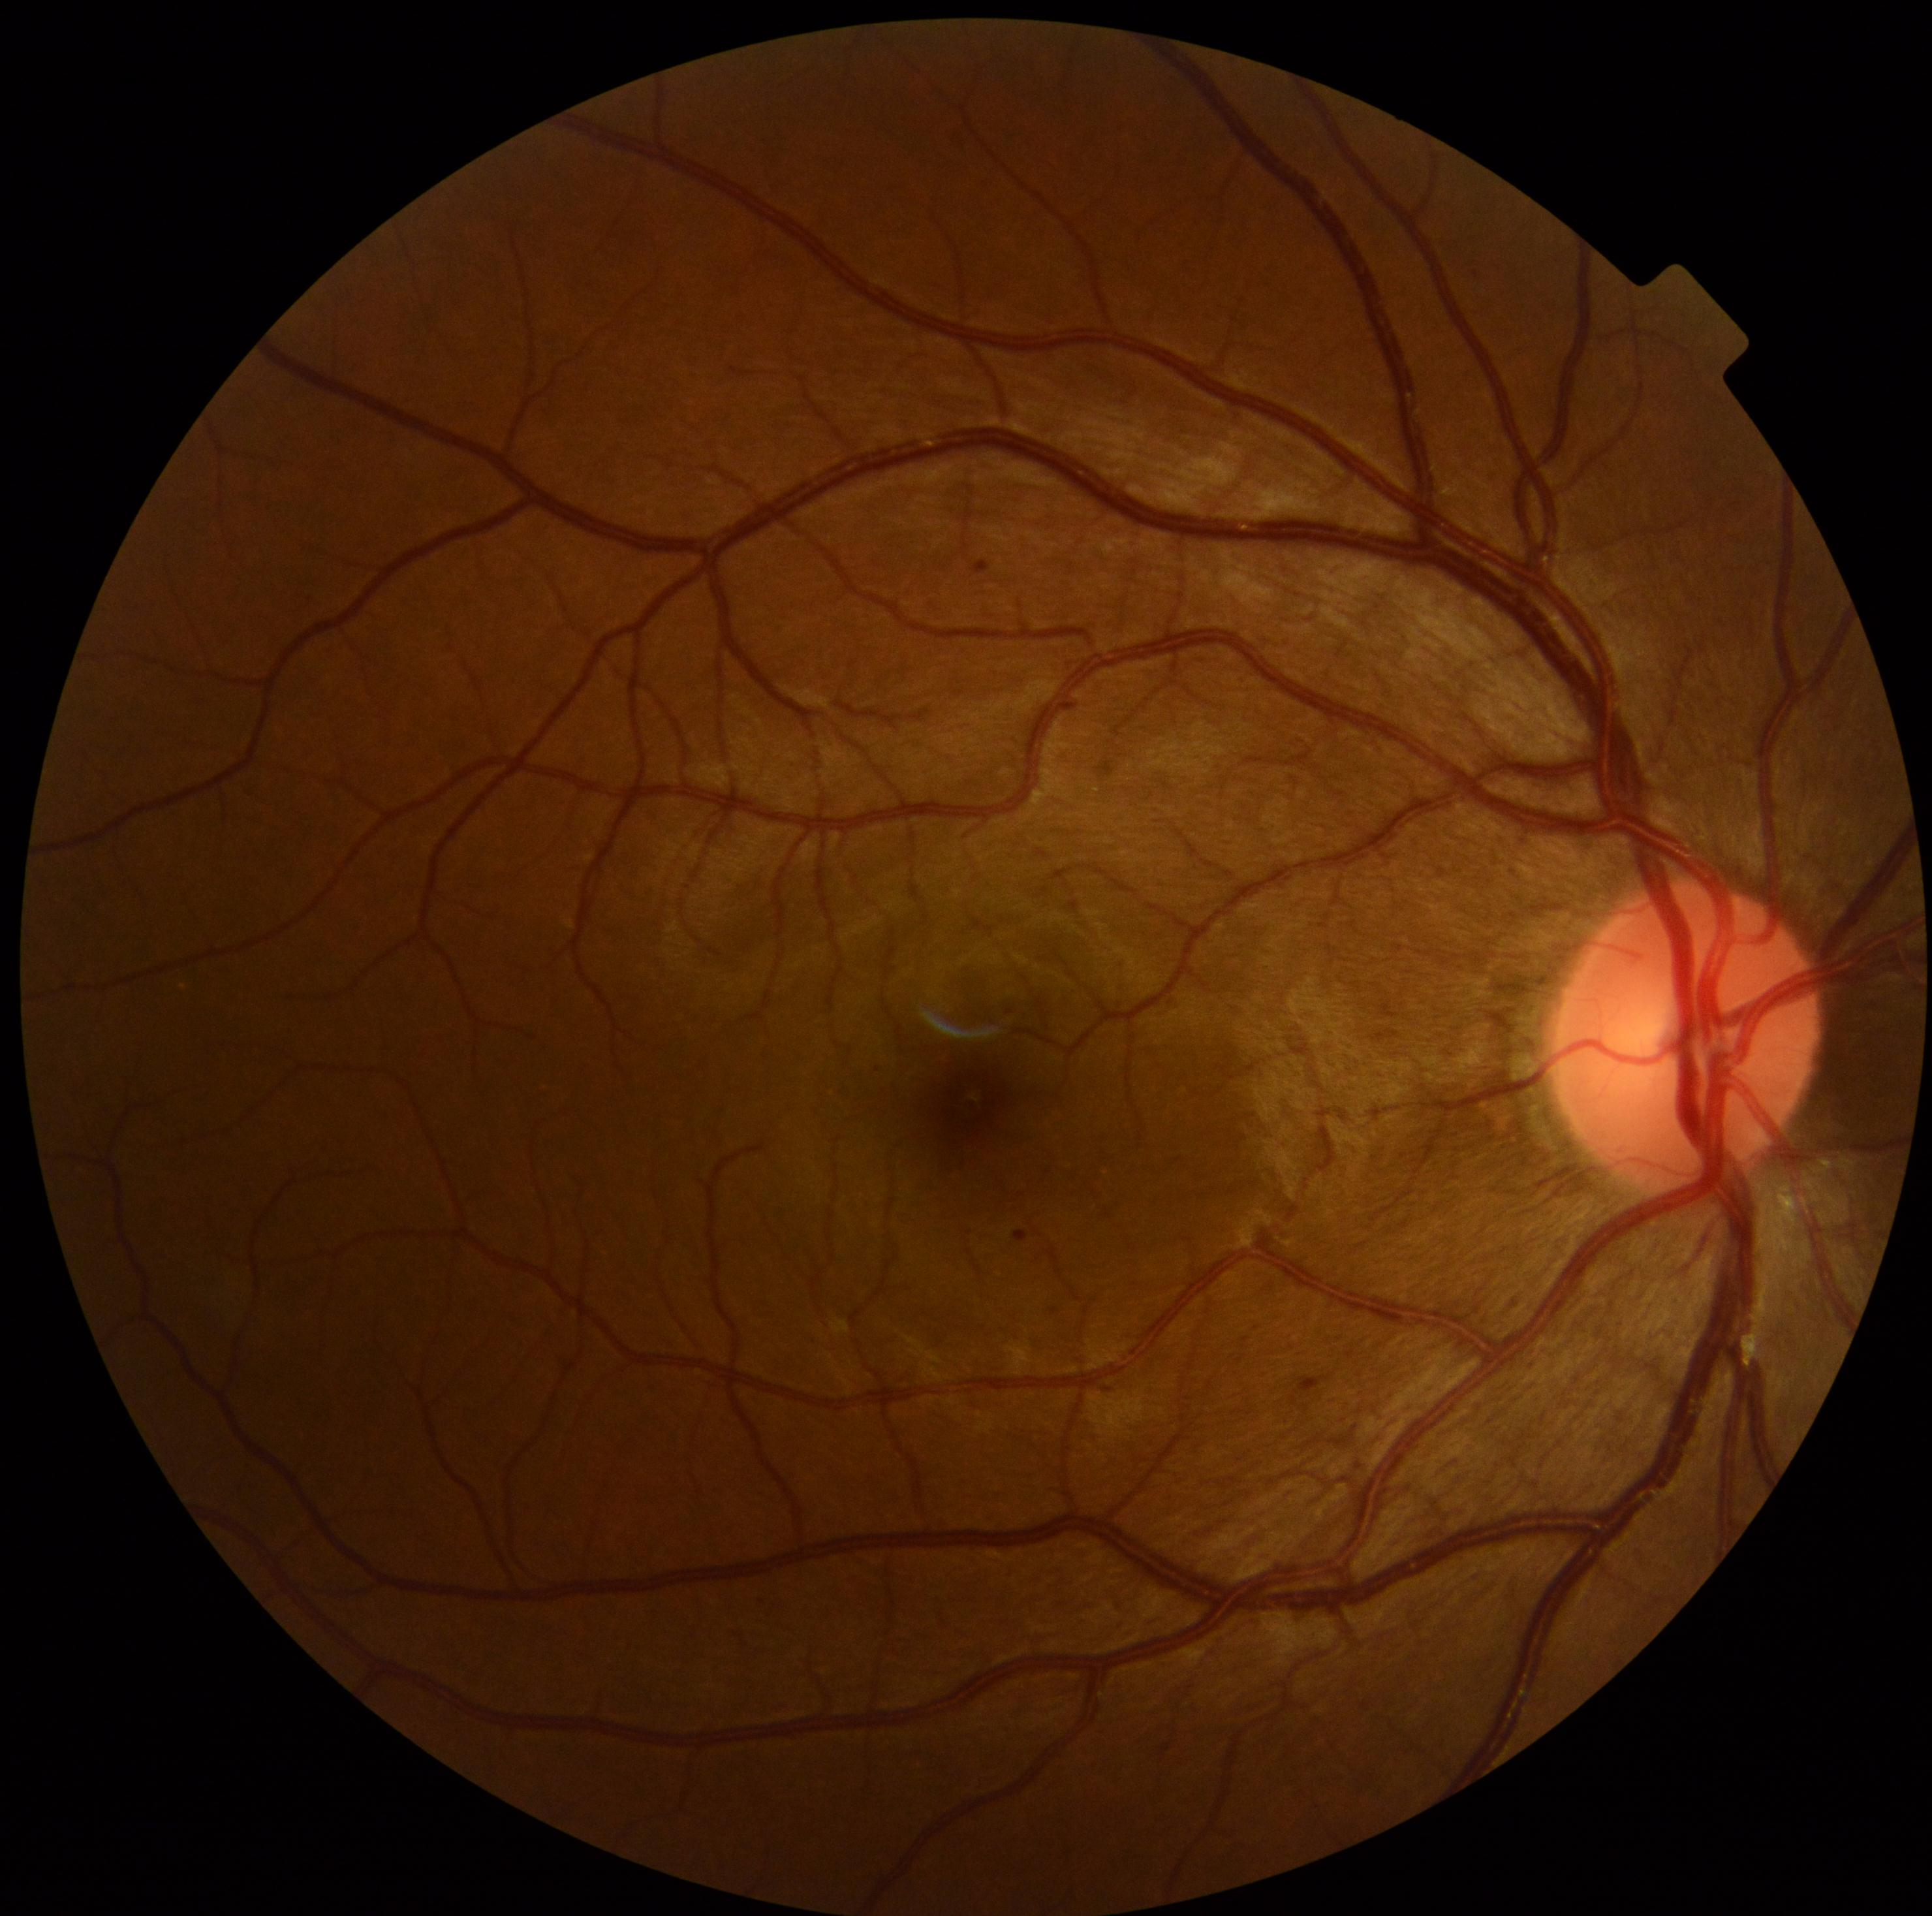

Diabetic retinopathy (DR) is grade 1 (mild NPDR). No hard exudates (EXs) identified. Microaneurysms (MAs) located at 1055, 701, 1068, 712 | 1014, 1231, 1029, 1242 | 973, 561, 991, 576 | 1104, 1389, 1112, 1393 | 1296, 1376, 1332, 1397 | 562, 1359, 569, 1372. MAs (small, approximate centers) near <point>878, 1069</point> | <point>1010, 1012</point> | <point>1055, 1311</point>. No soft exudates (SEs) identified. No hemorrhages (HEs) identified.